Retinal fundus photograph · 2102 x 1736 pixels
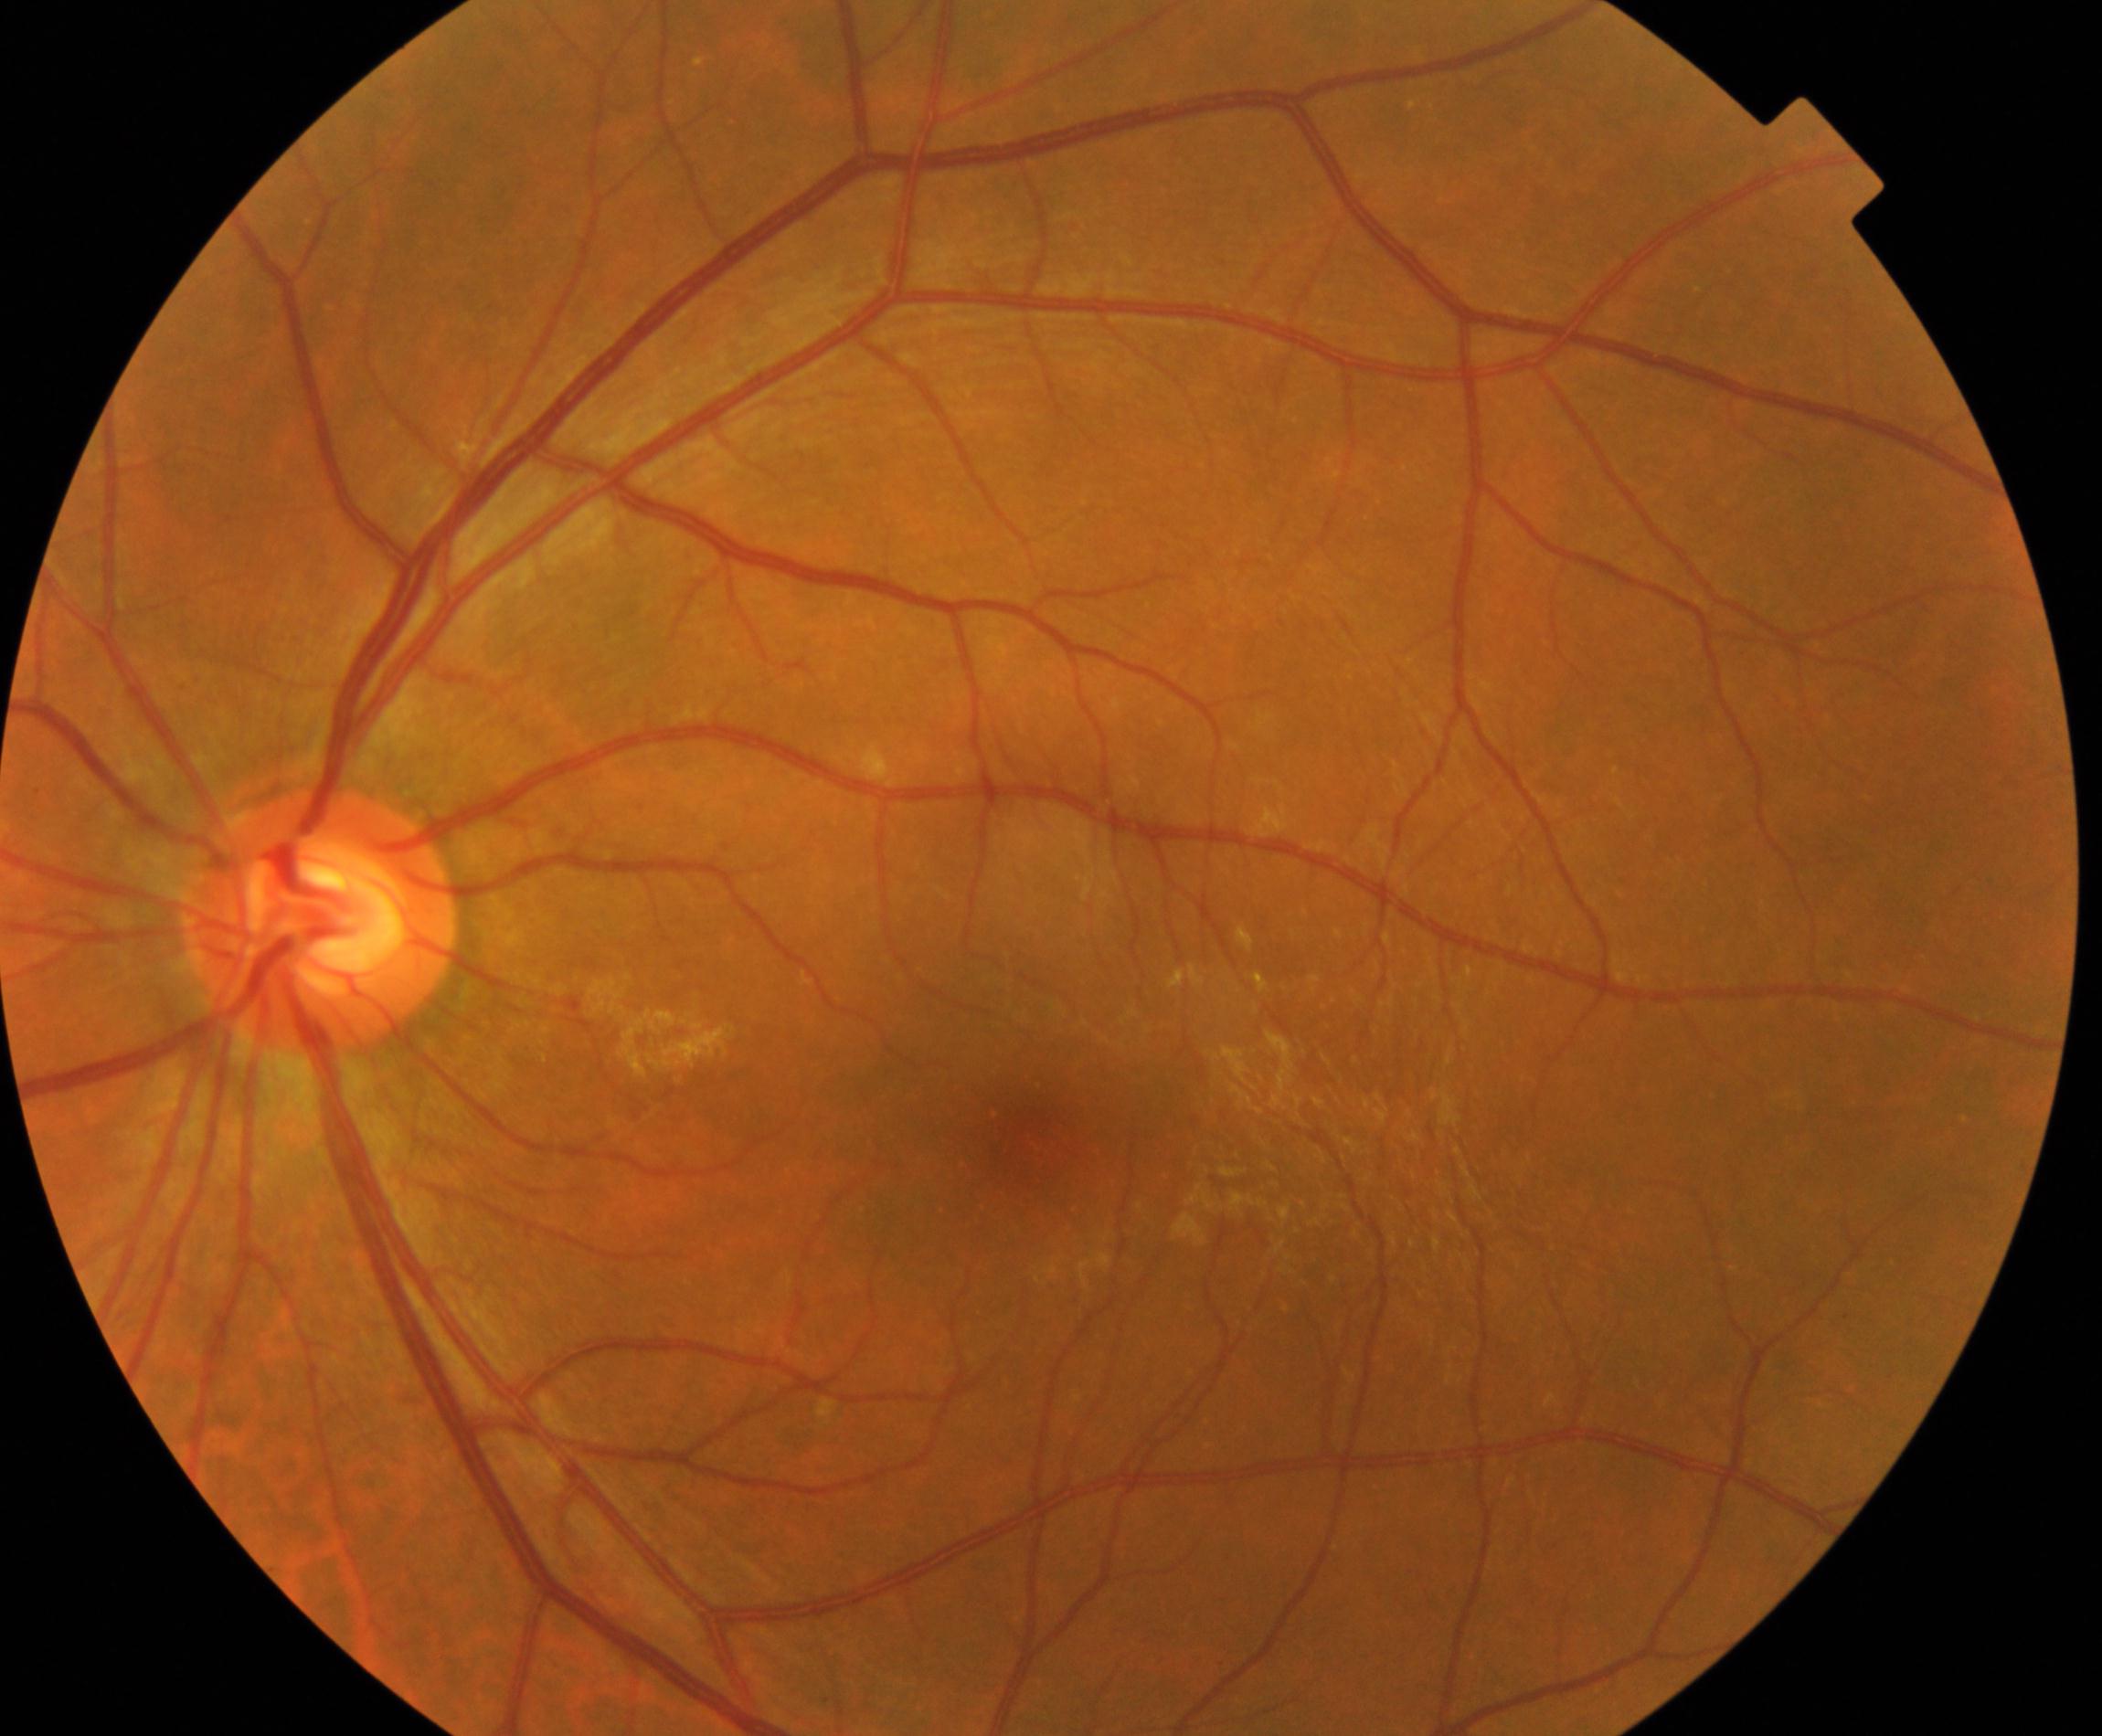
Classification: epiretinal membrane.